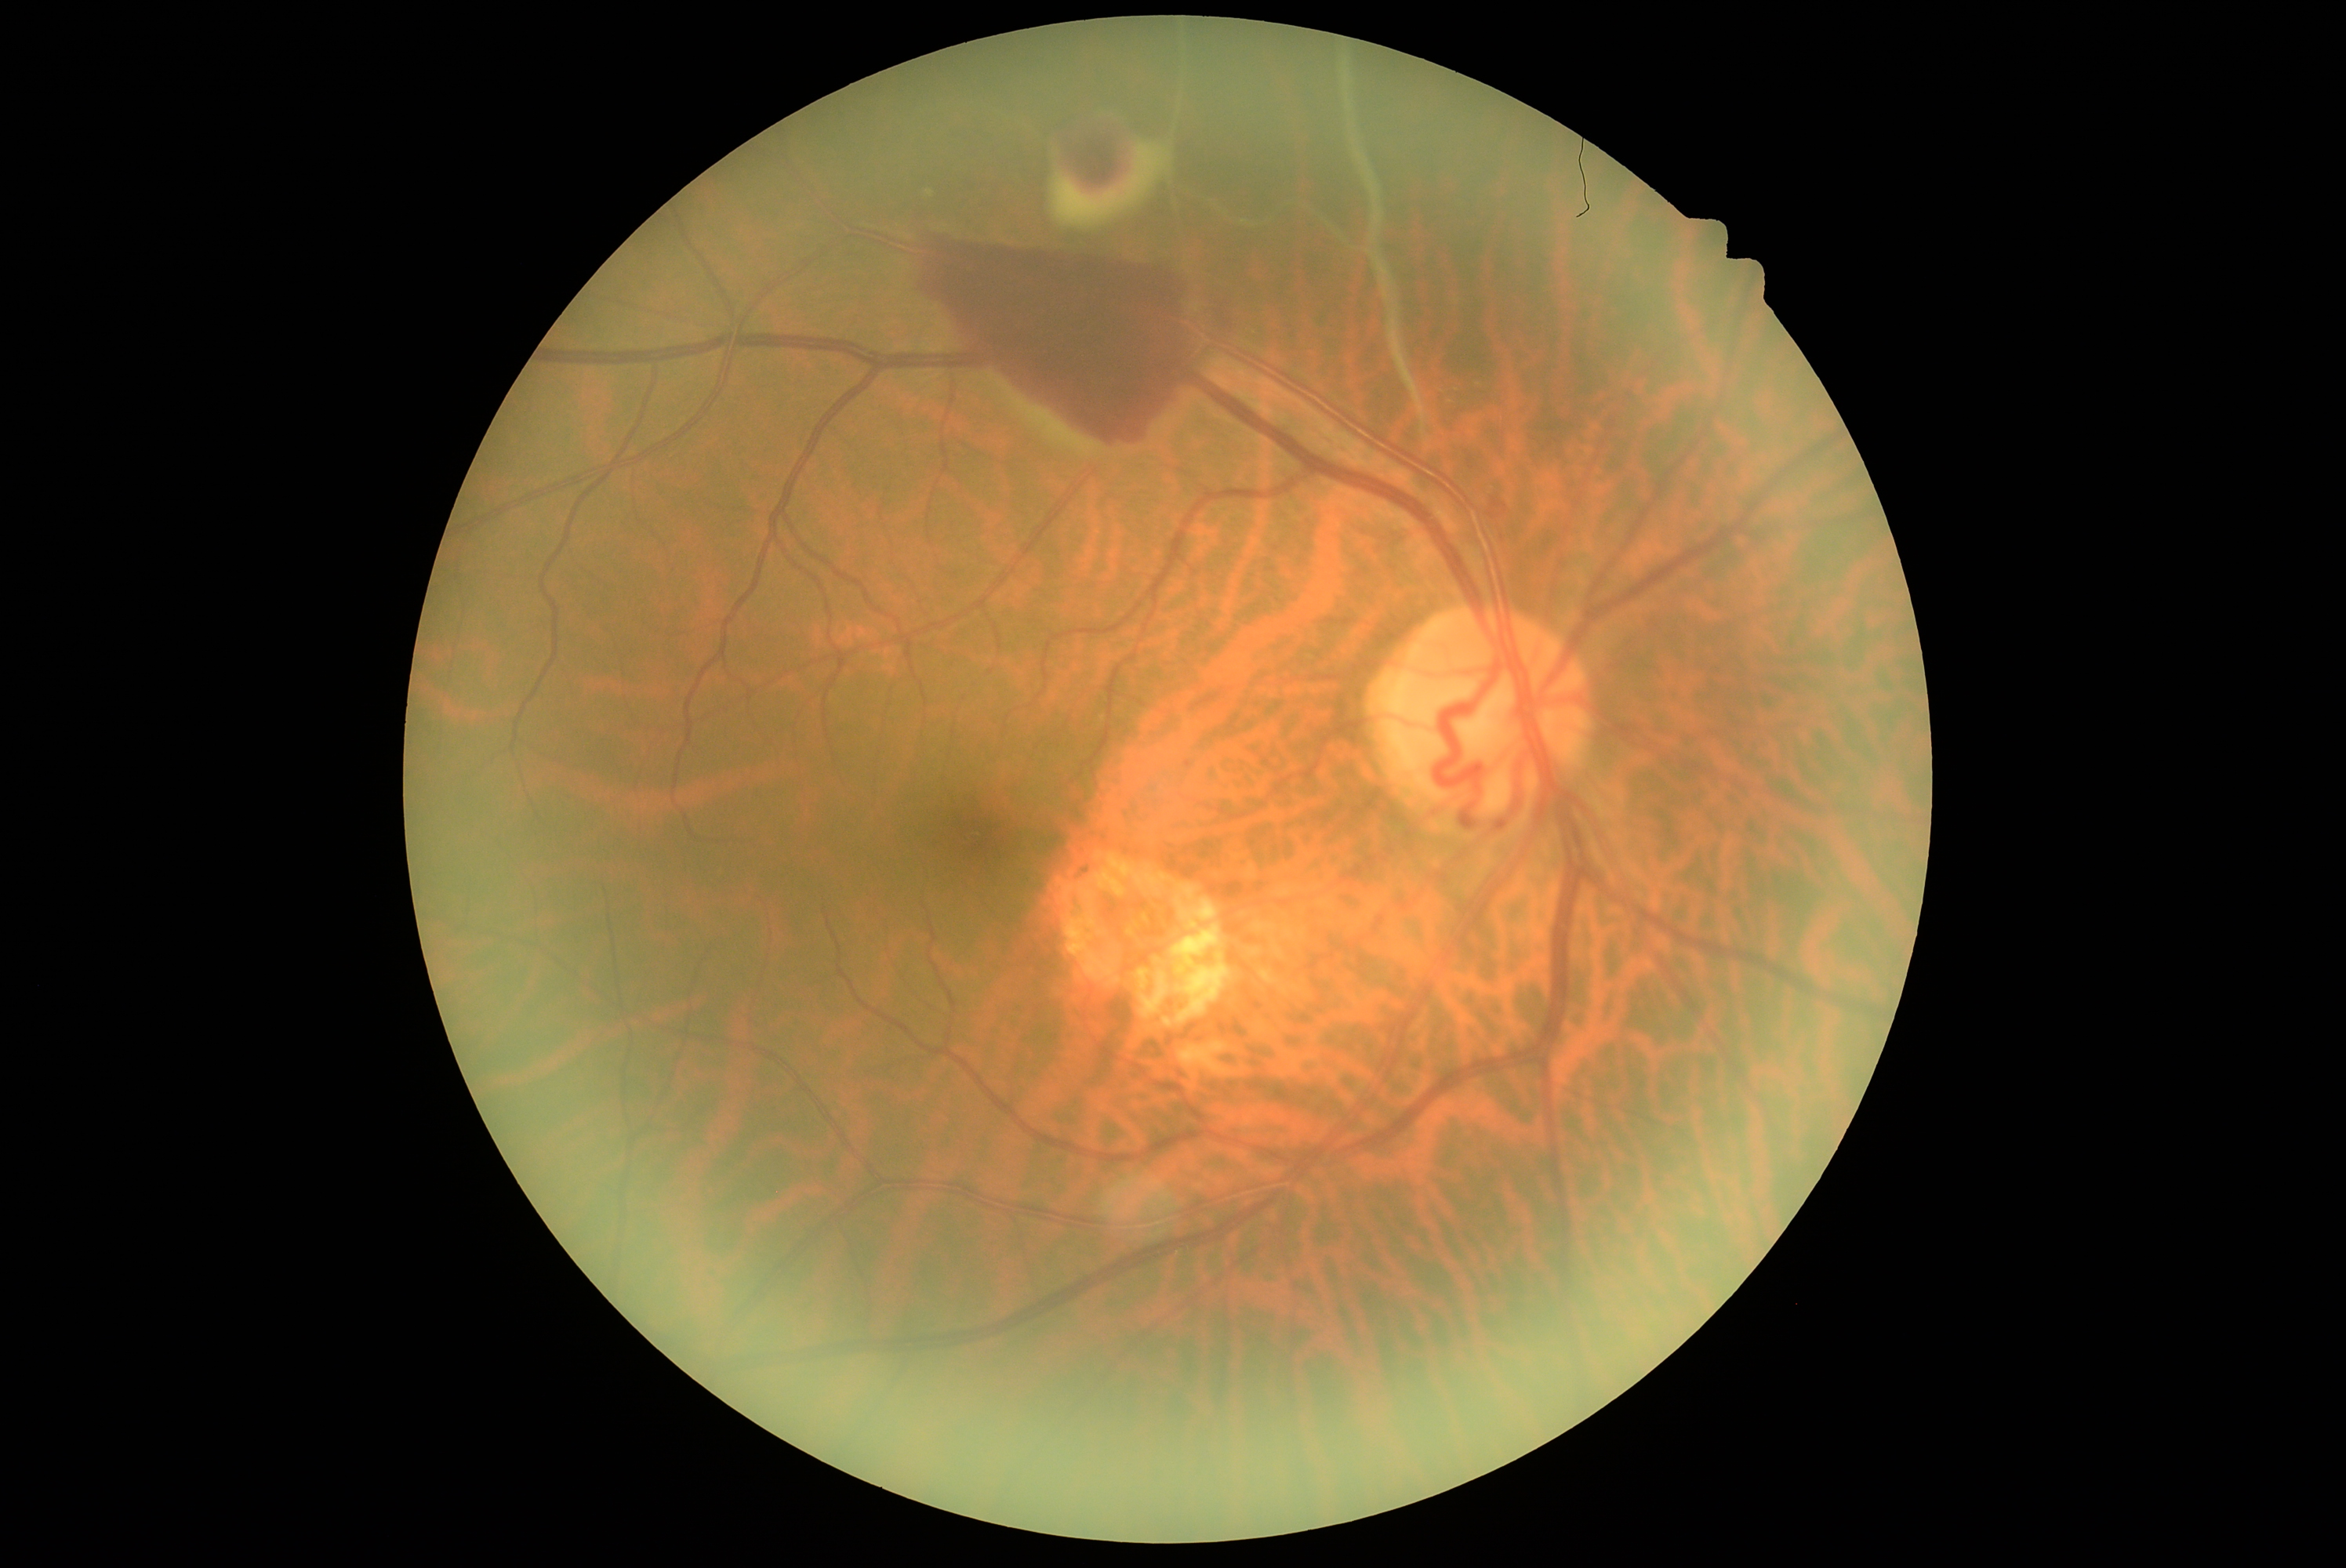
DR: proliferative diabetic retinopathy (grade 4), DR class: proliferative diabetic retinopathy.